Image size 1240x1240; acquired on the Phoenix ICON; infant wide-field retinal image.
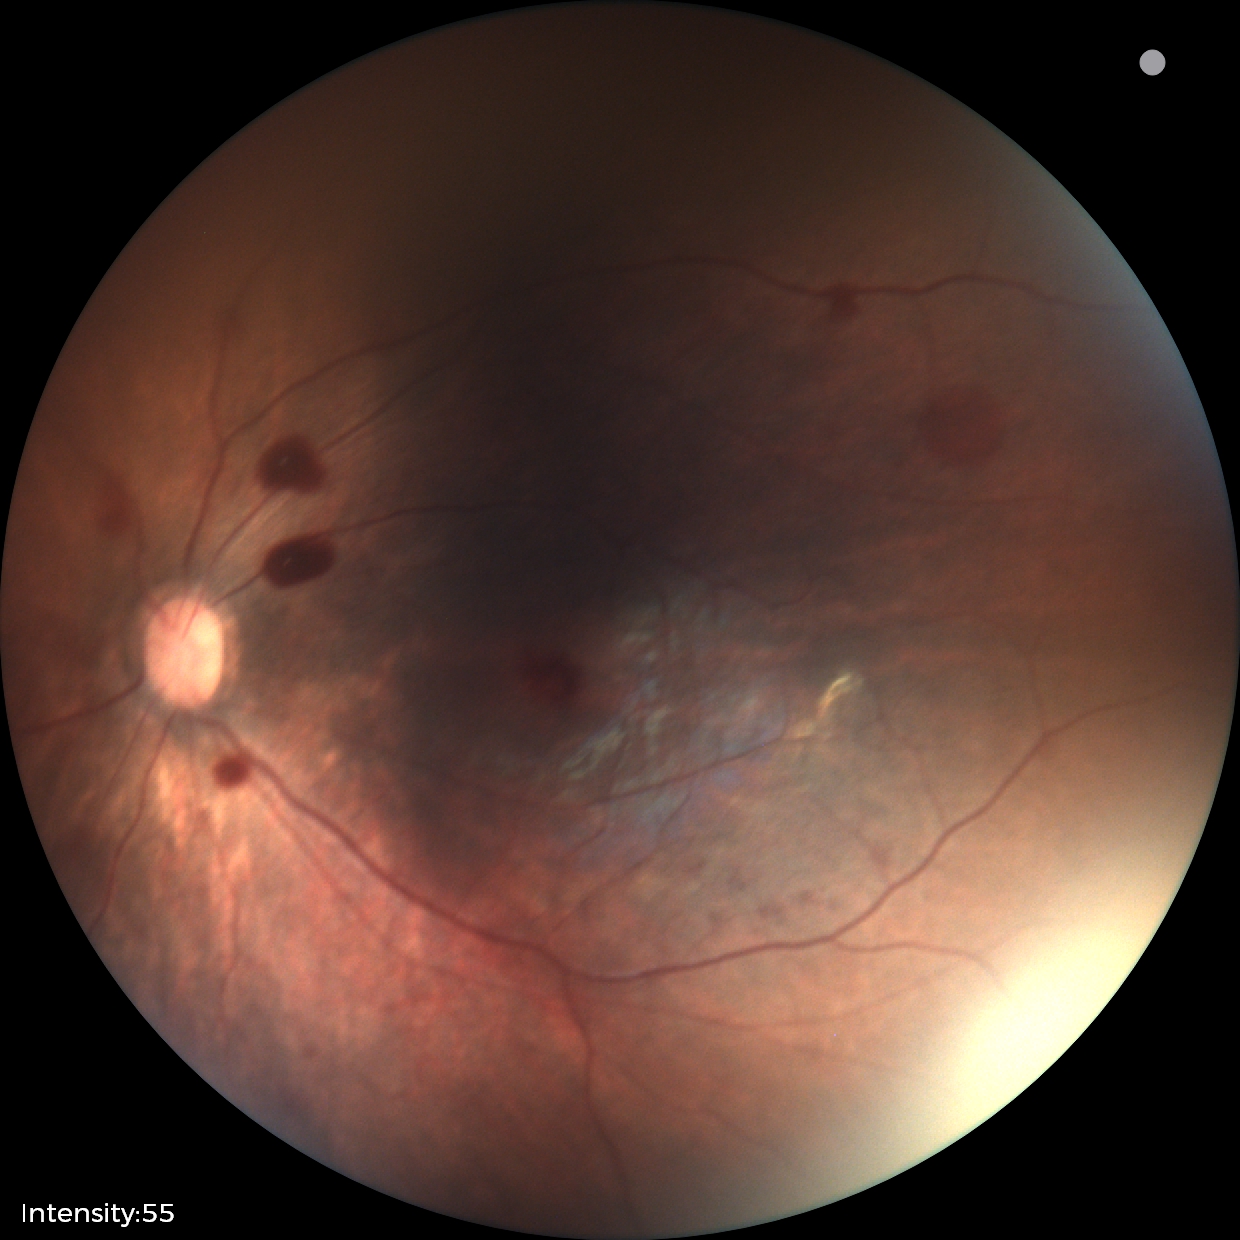 Assessment: retinal hemorrhages